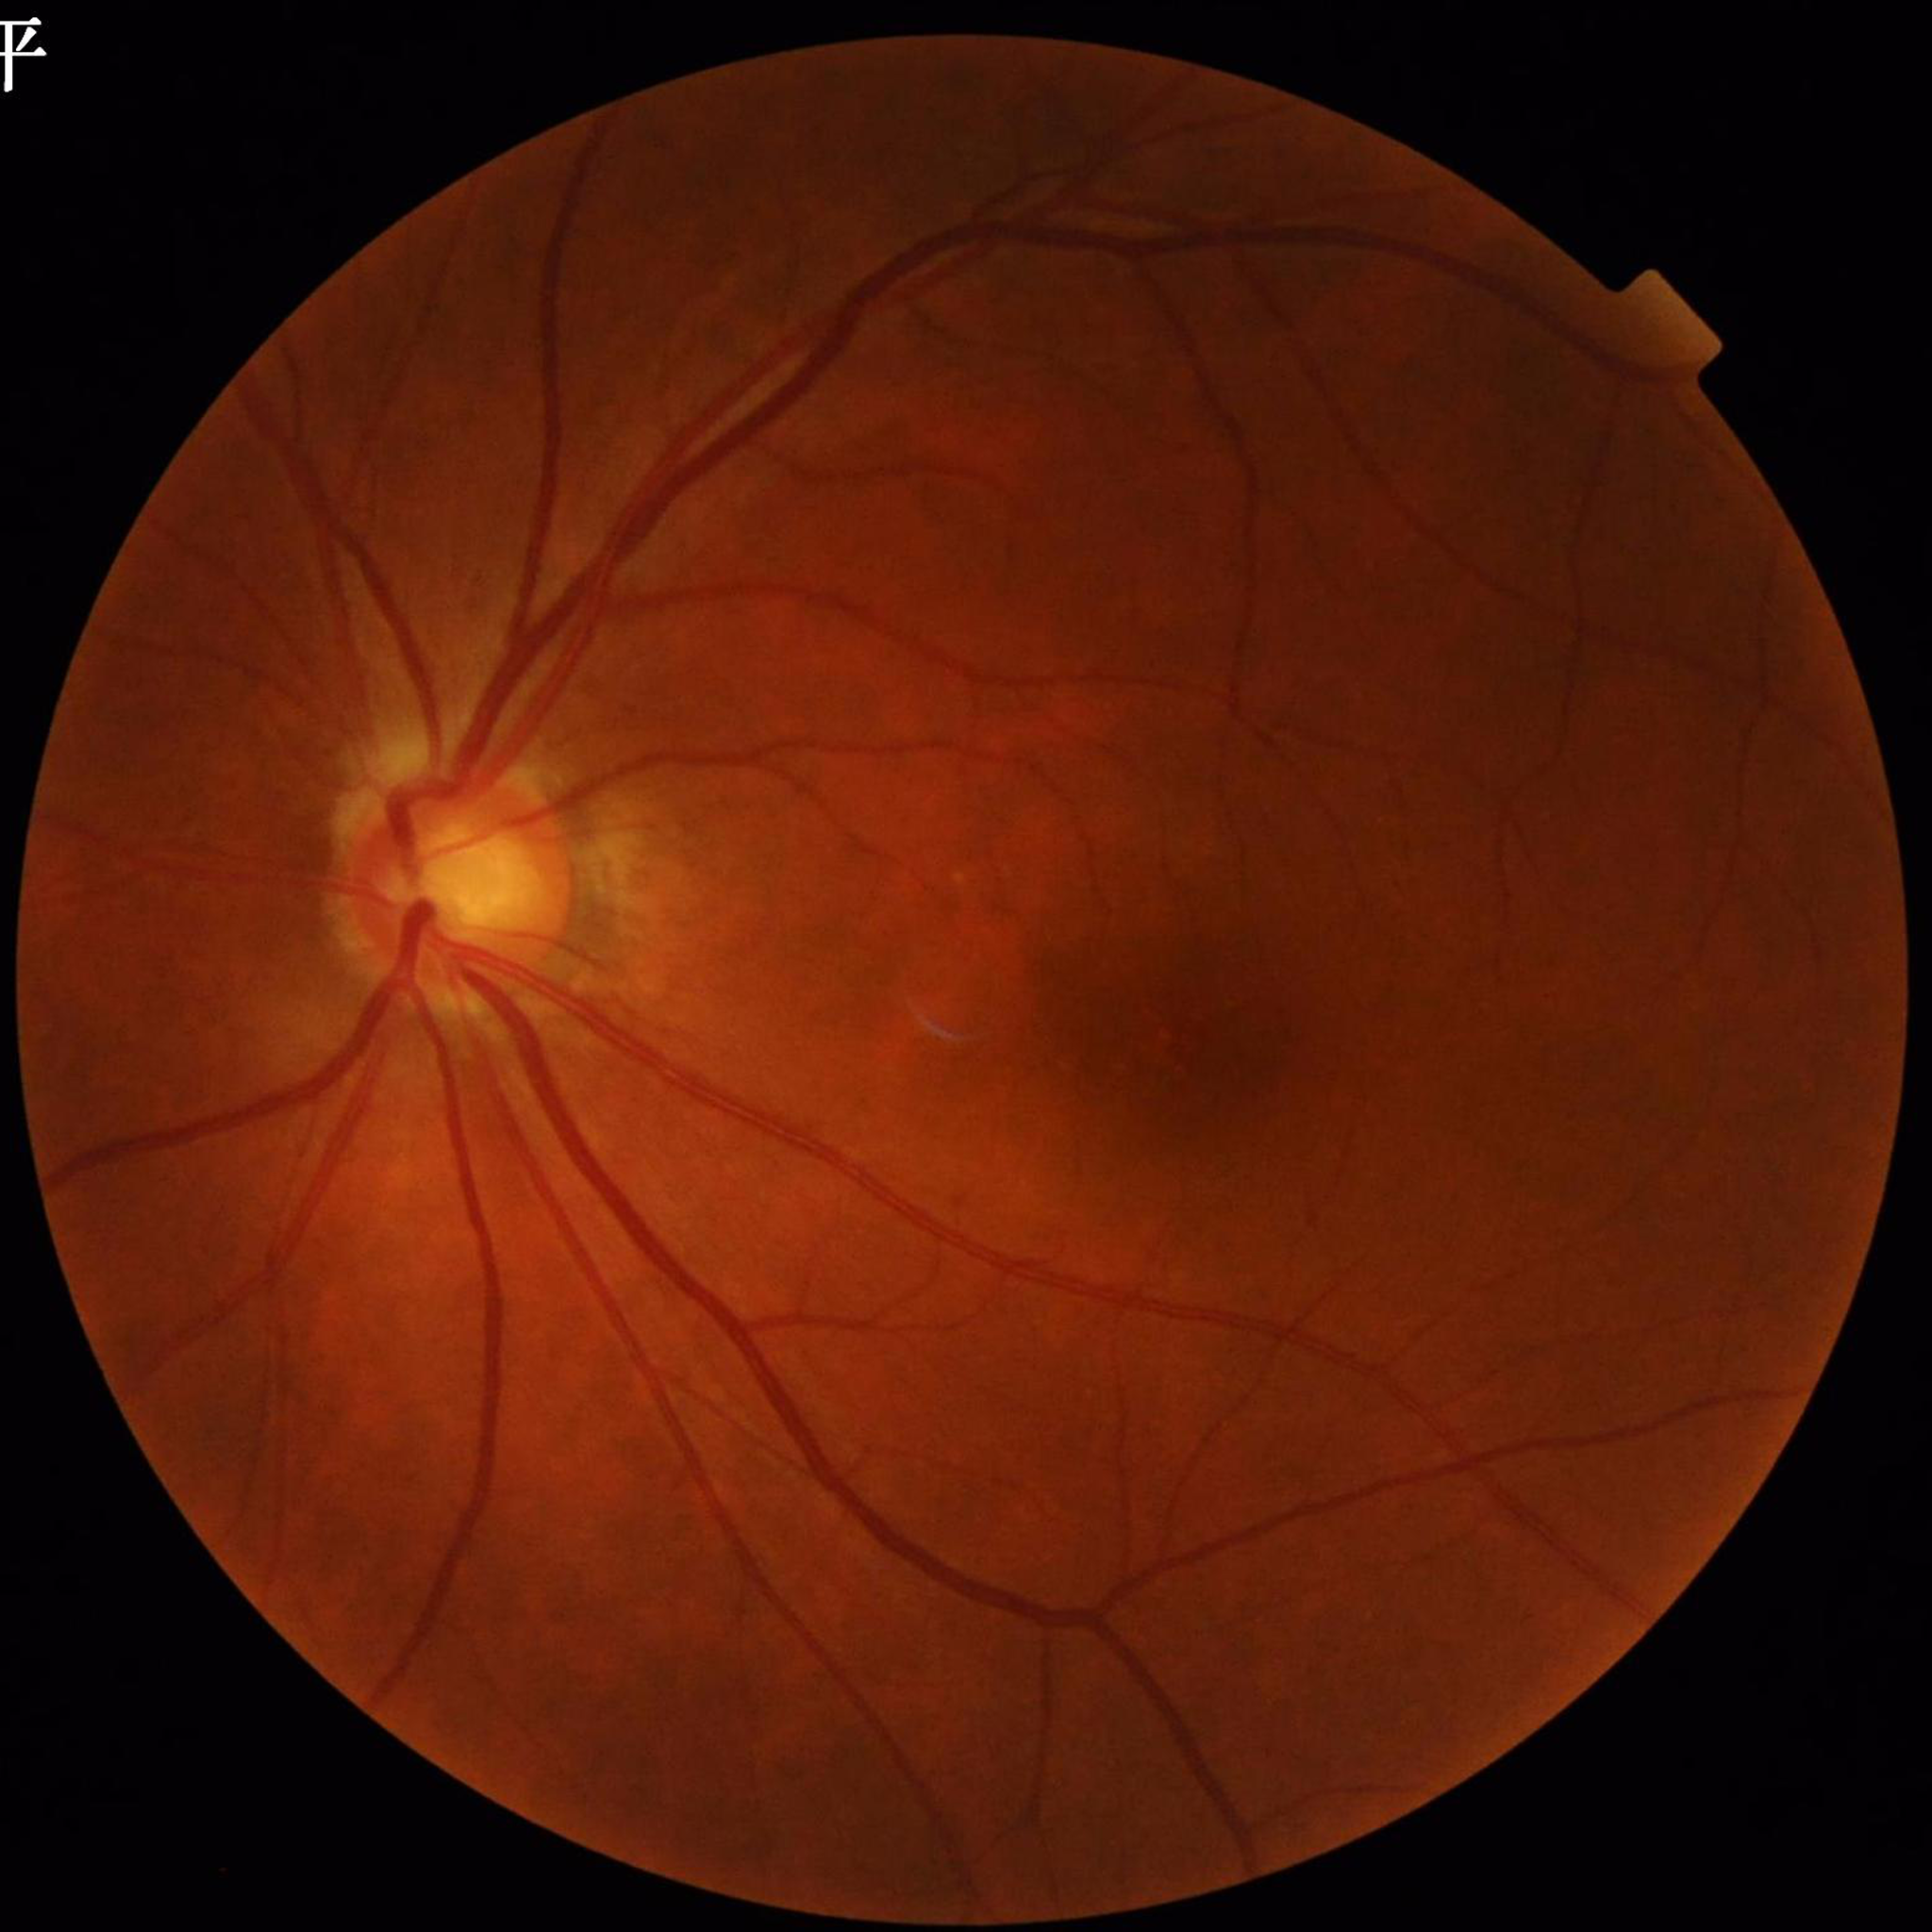
{
  "diagnosis": "glaucoma"
}